45° field of view · modified Davis grading · 848x848px — 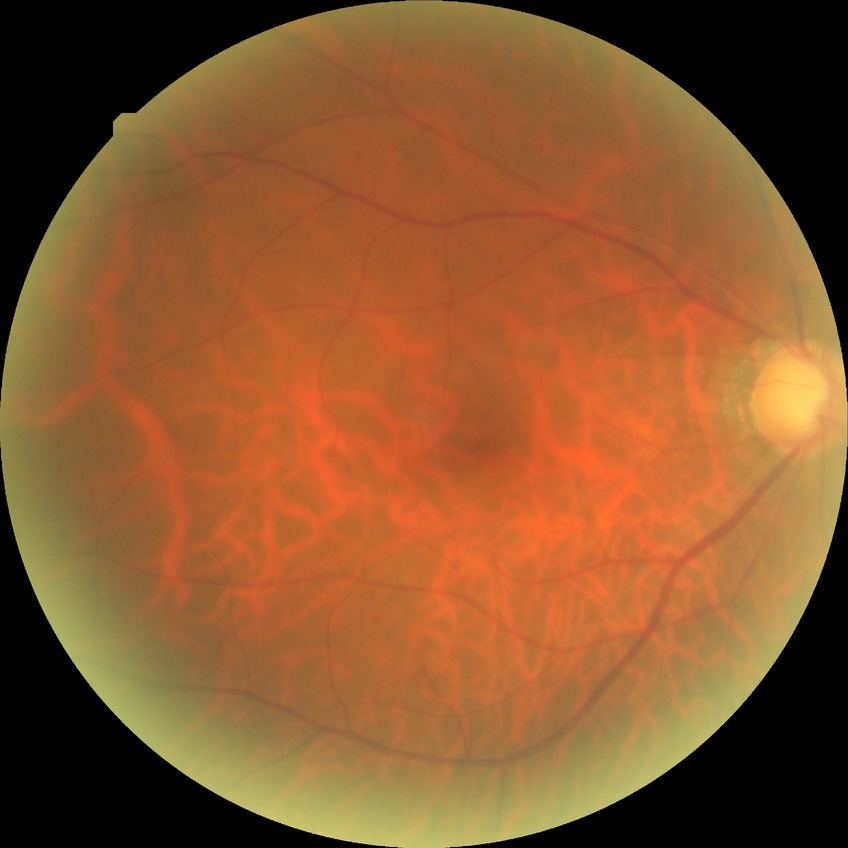 Diabetic retinopathy (DR) is no diabetic retinopathy (NDR).